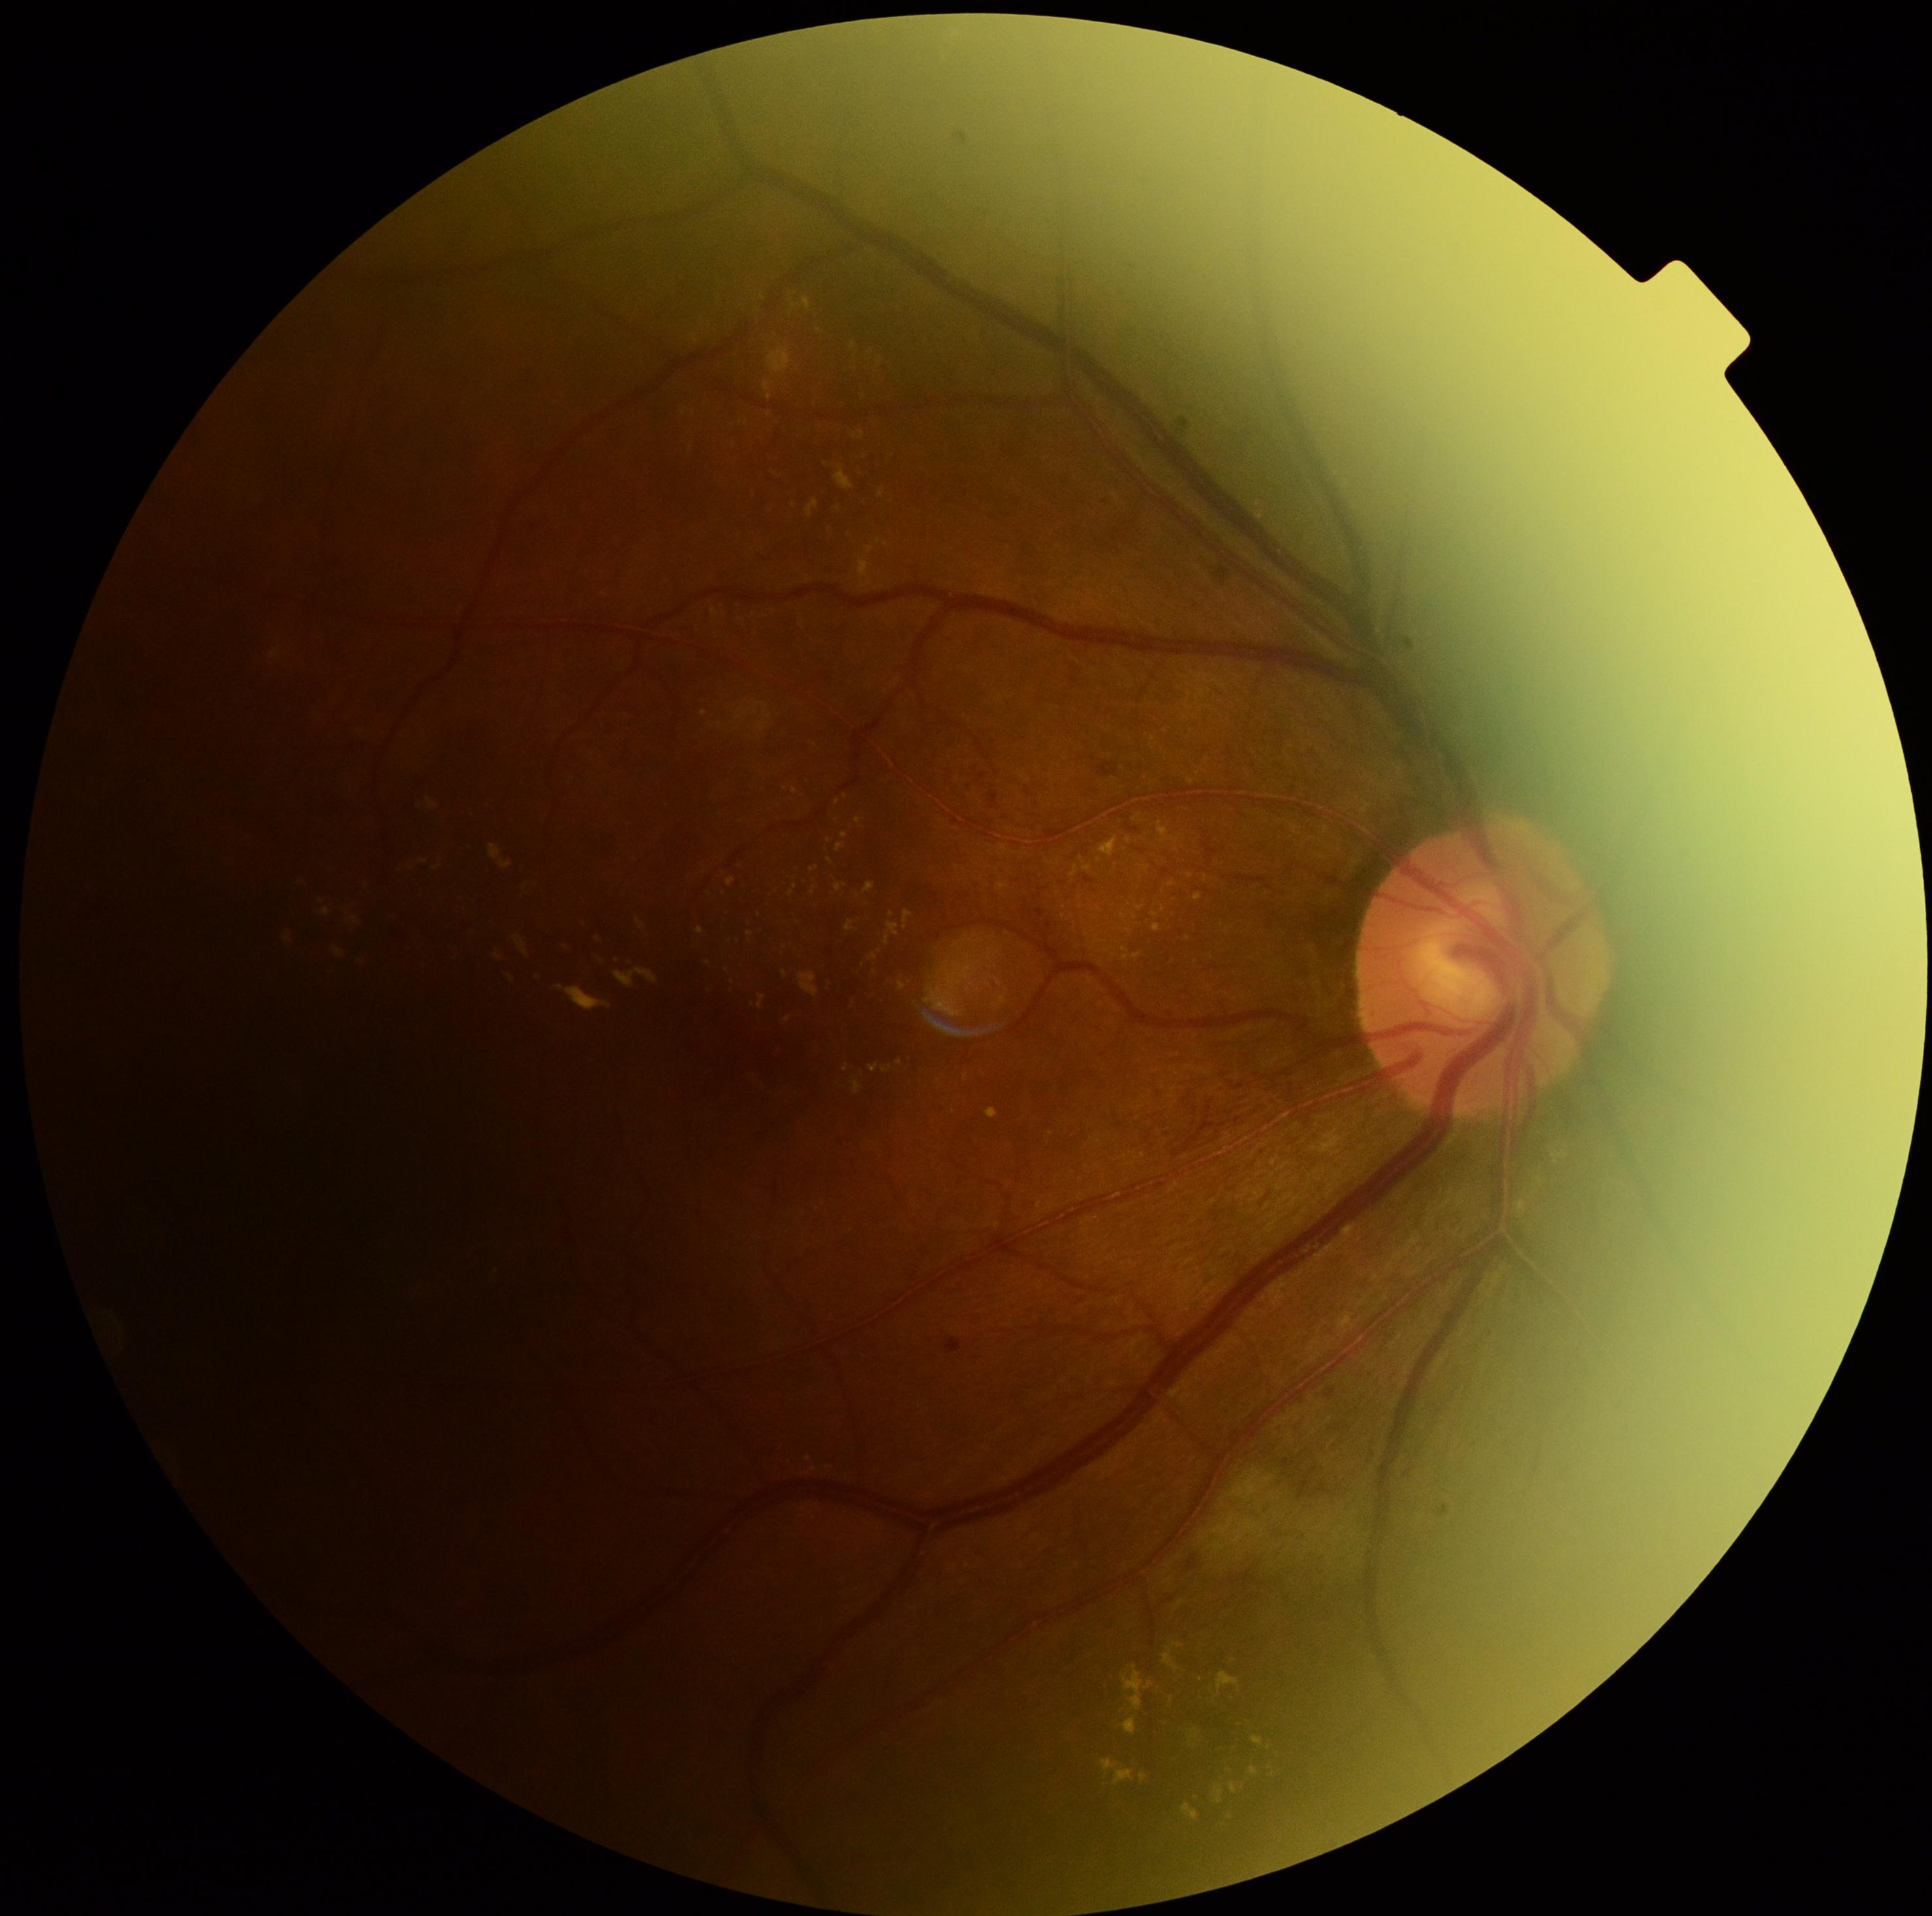 Annotations:
- diabetic retinopathy (DR) — moderate NPDR (grade 2)